Modified Davis classification.
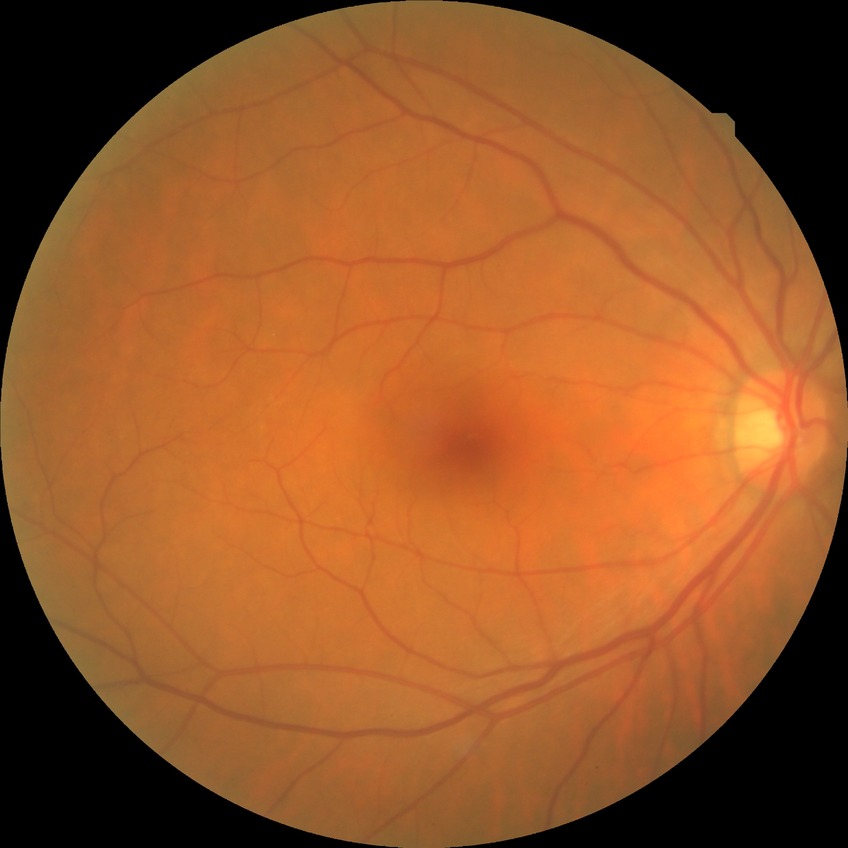   davis_grade: no diabetic retinopathy